Modified Davis grading — 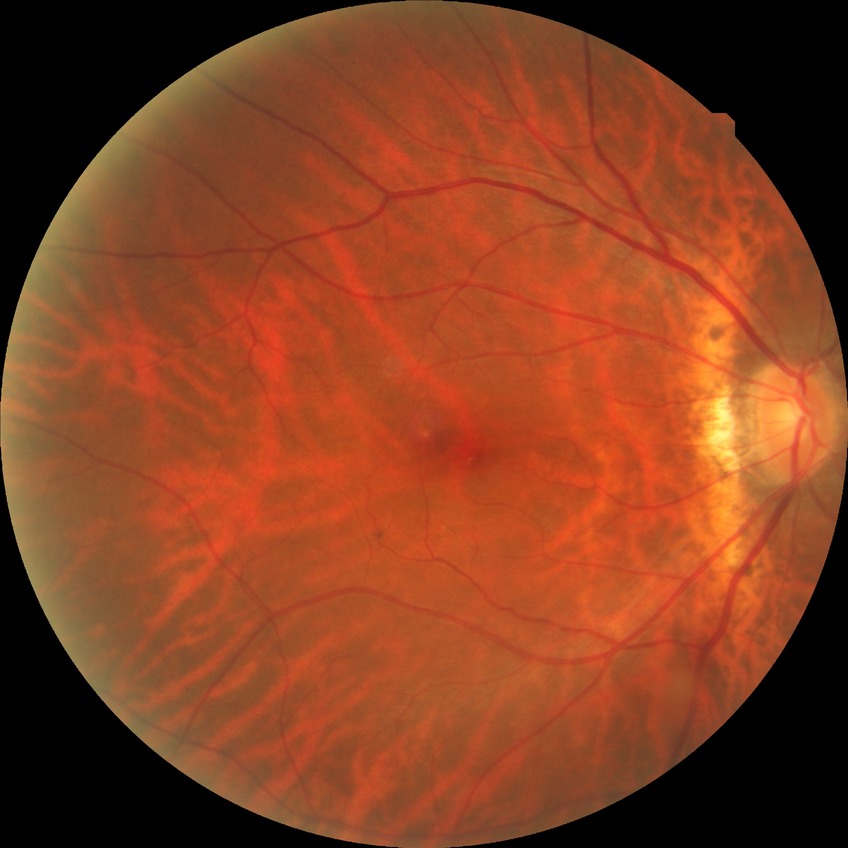
{
  "davis_grade": "no diabetic retinopathy"
}